1534x1534. Tabletop color fundus camera image. 50-degree field of view — 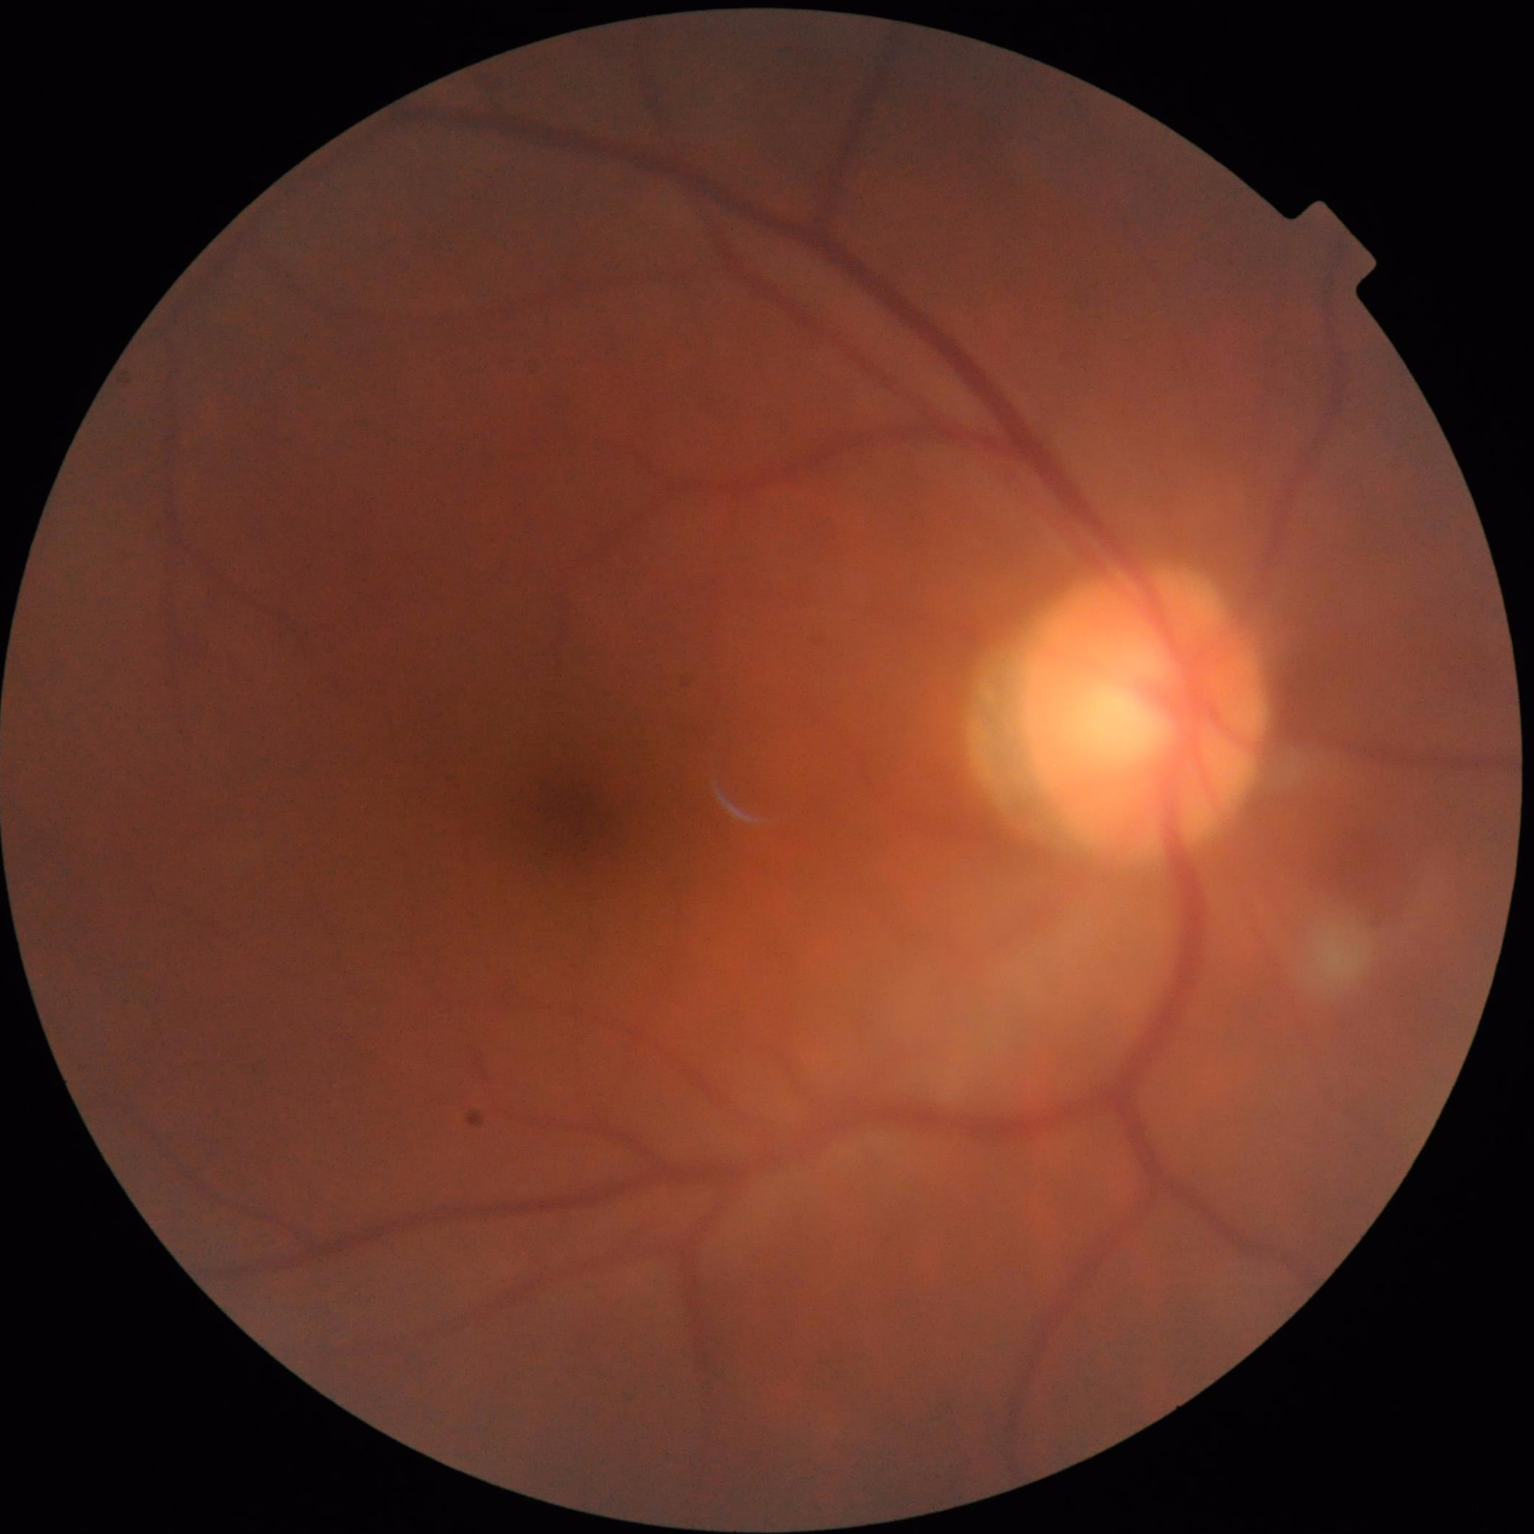 {
  "contrast": "good",
  "overall_quality": "poor",
  "illumination": "satisfactory",
  "clarity": "poor"
}